2212 x 1659 pixels; color fundus image:
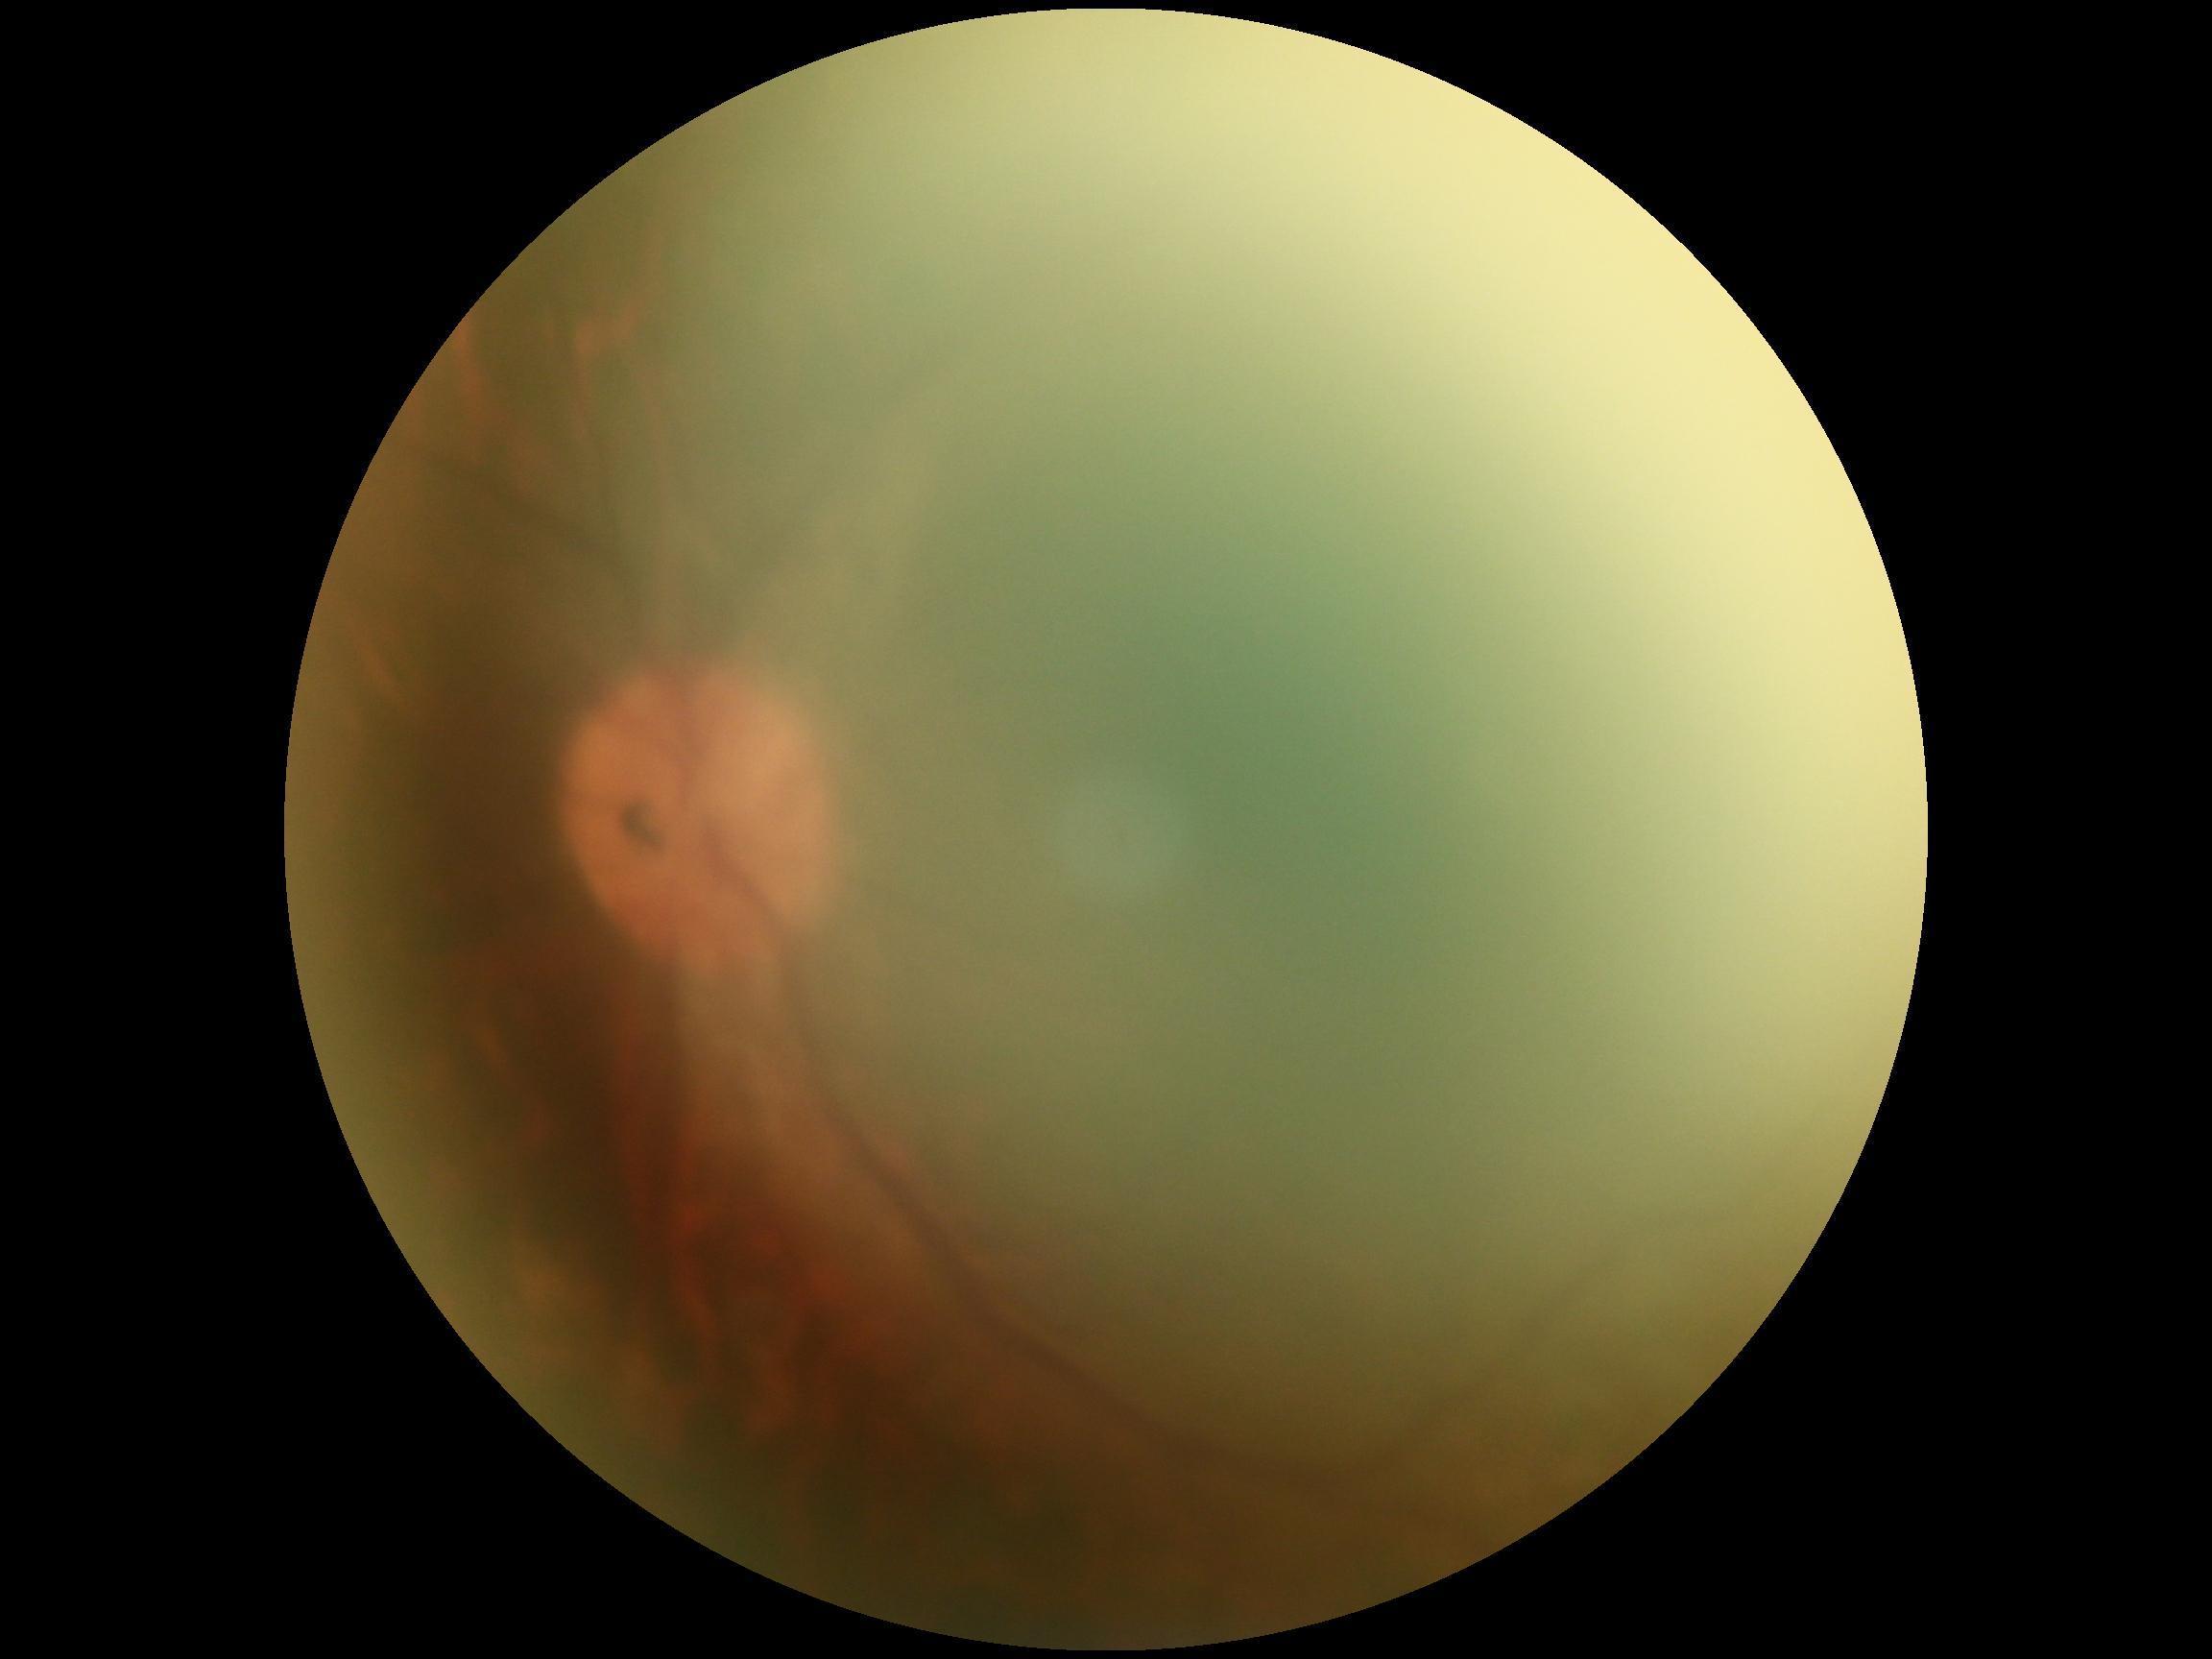

DR: ungradable due to poor image quality.